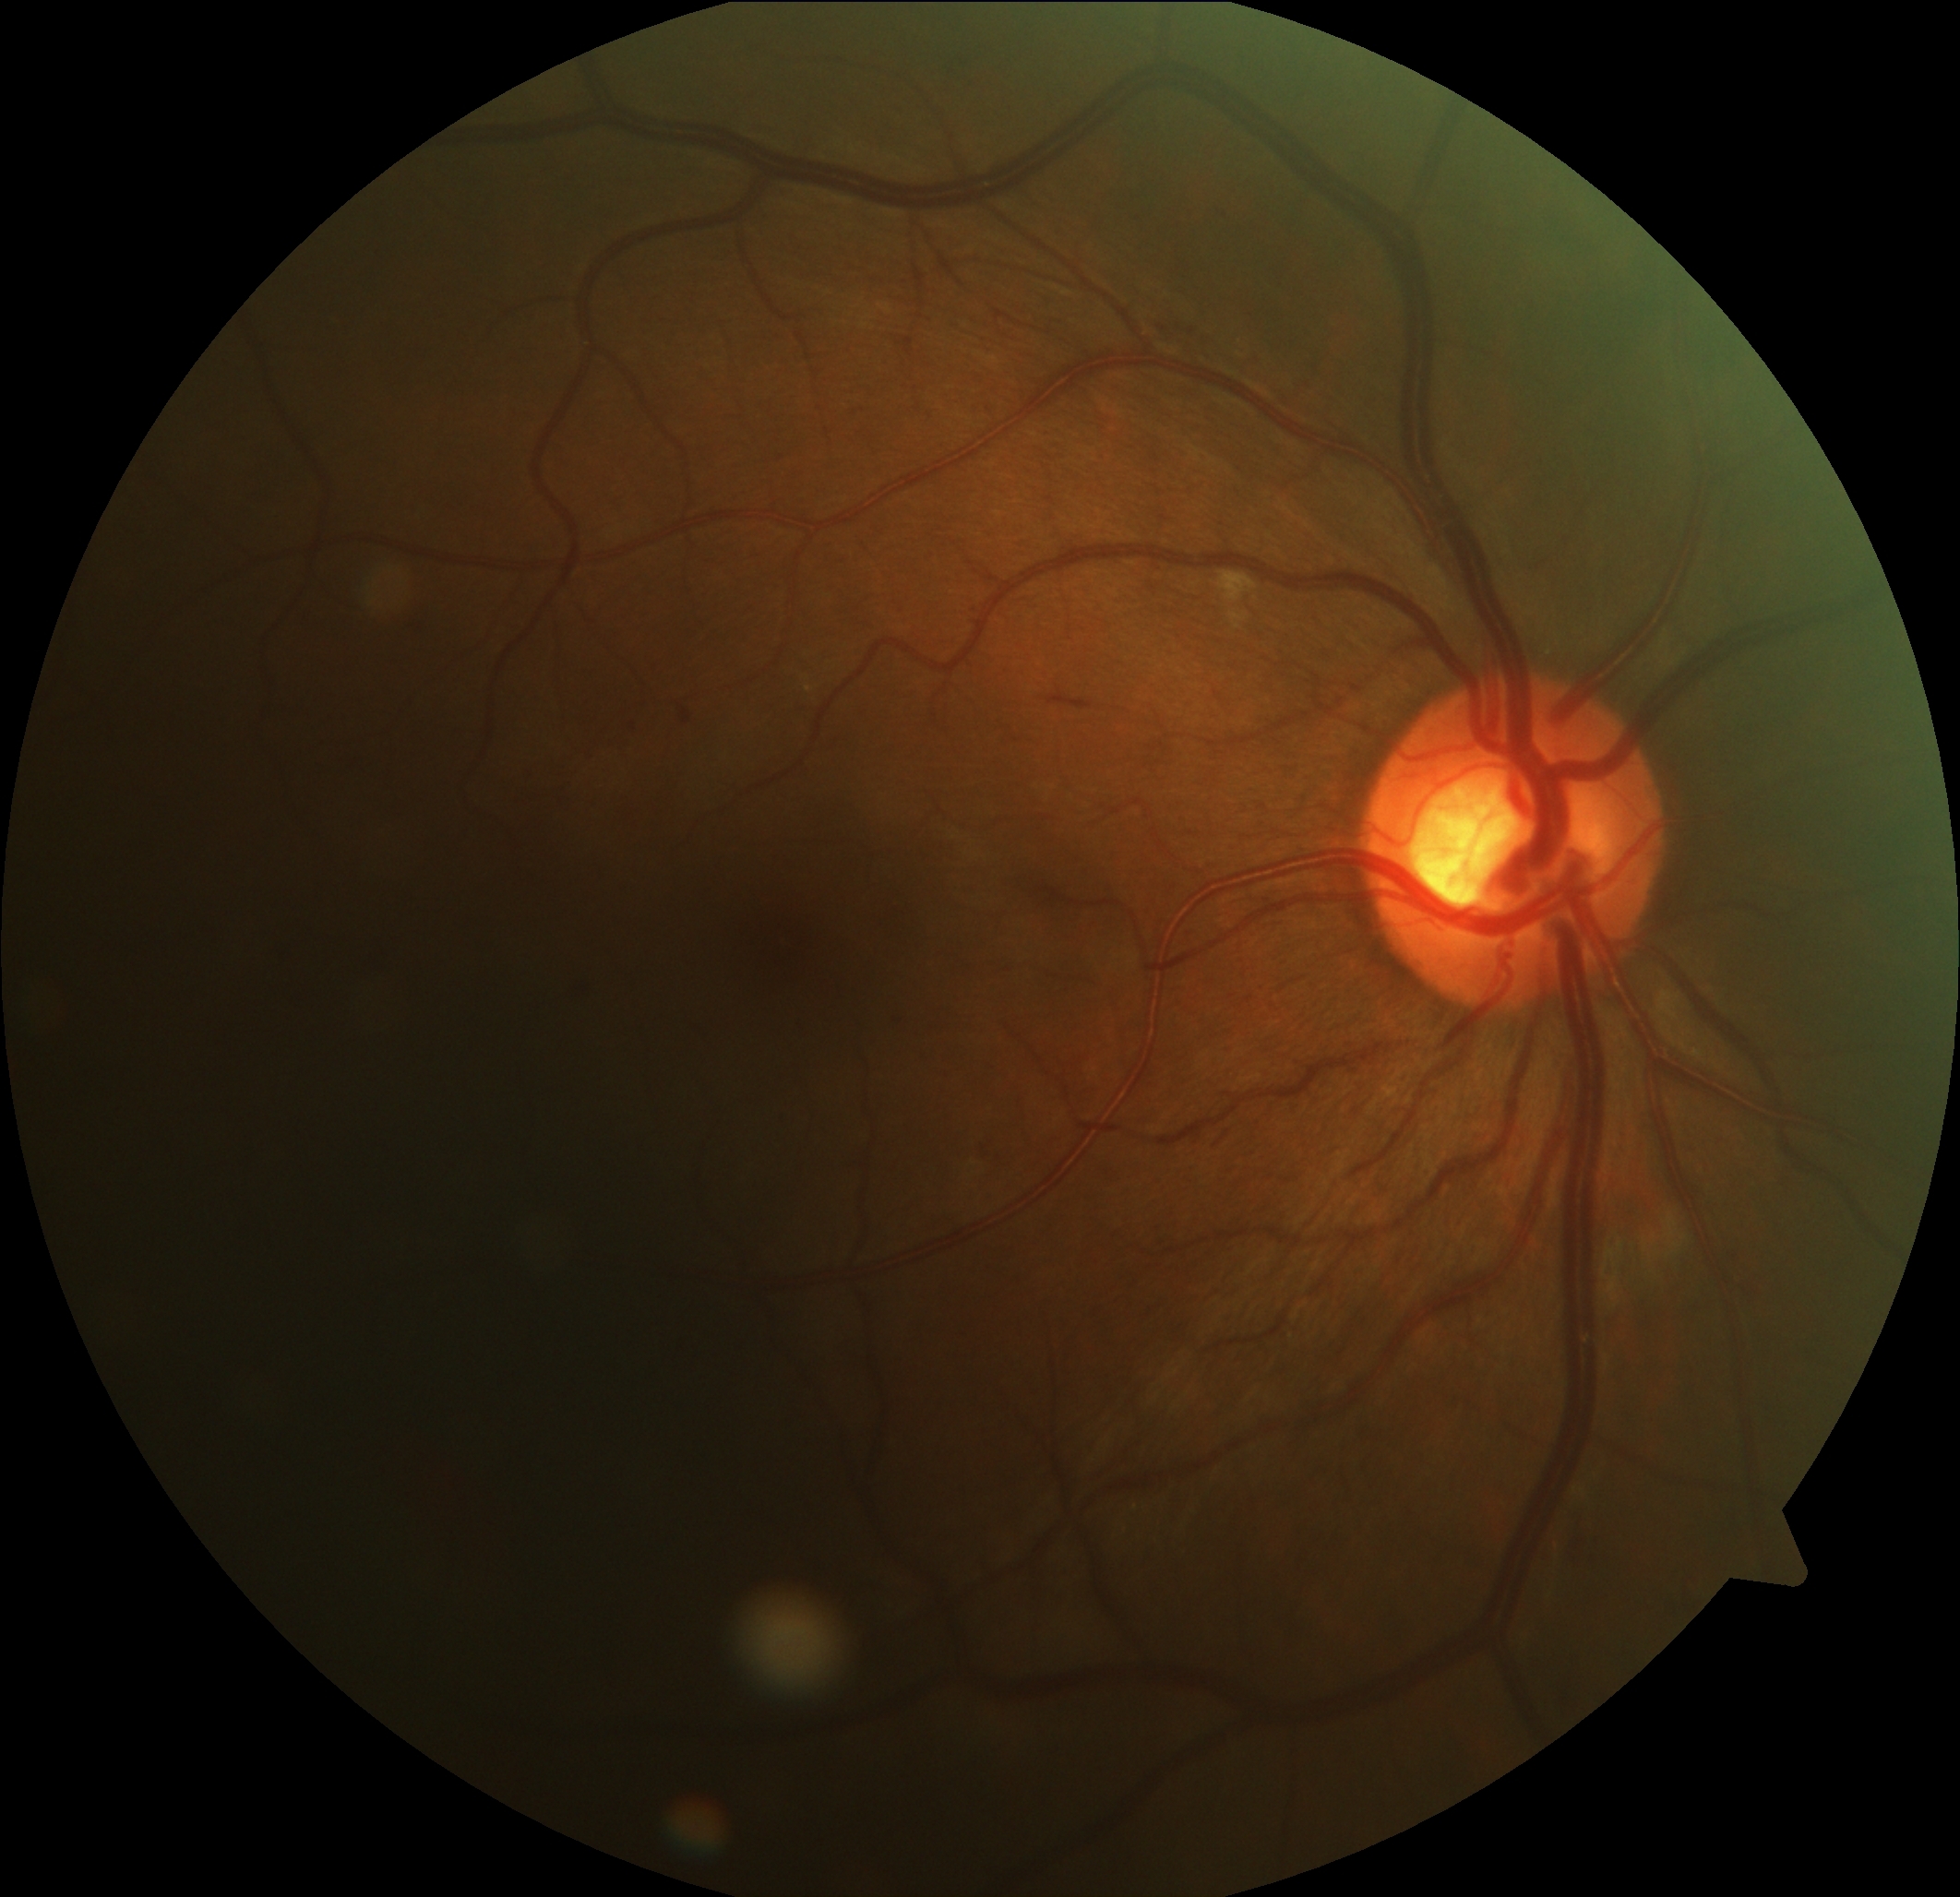

DR = 2/4.